2212x1659 · retinal fundus photograph:
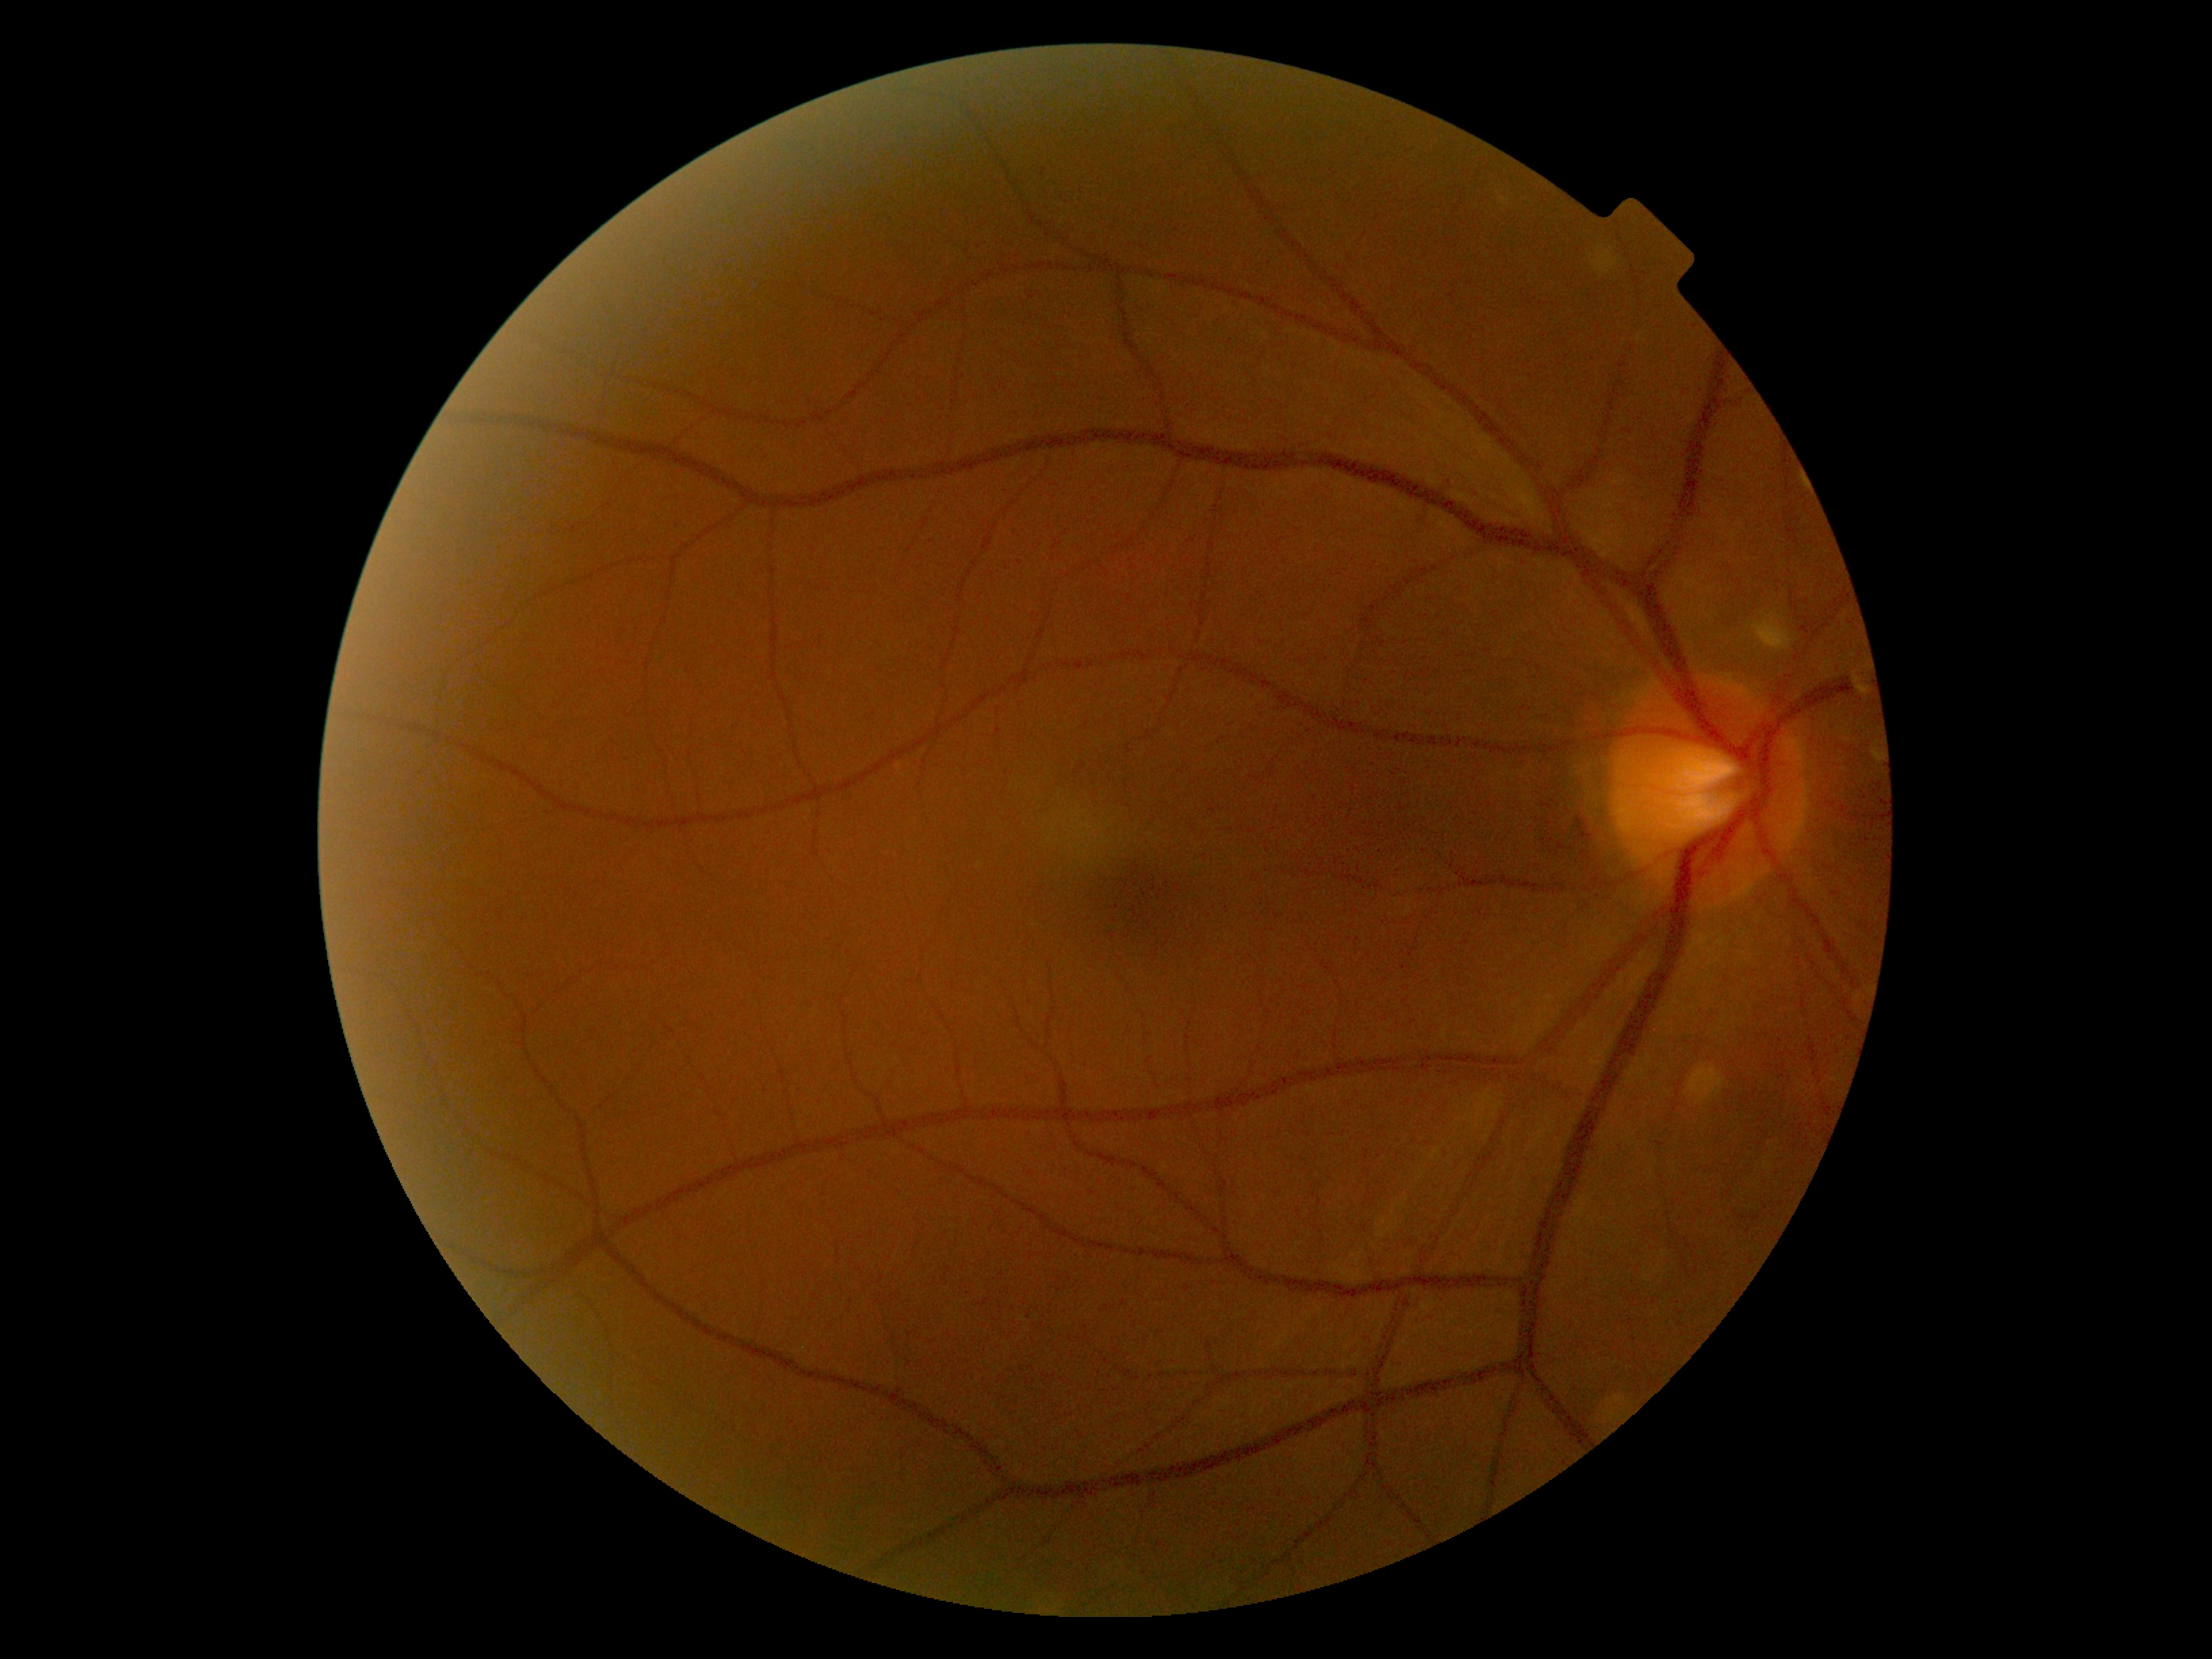

DR severity = no apparent diabetic retinopathy (grade 0) — no visible signs of diabetic retinopathy